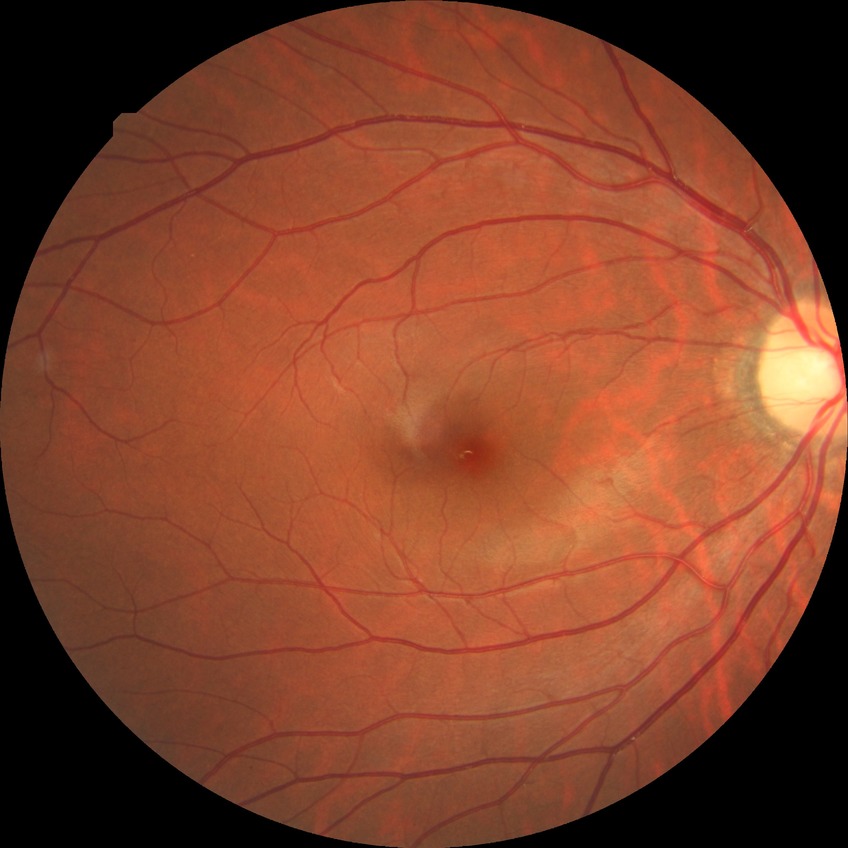
No signs of diabetic retinopathy.
Davis grade is NDR.